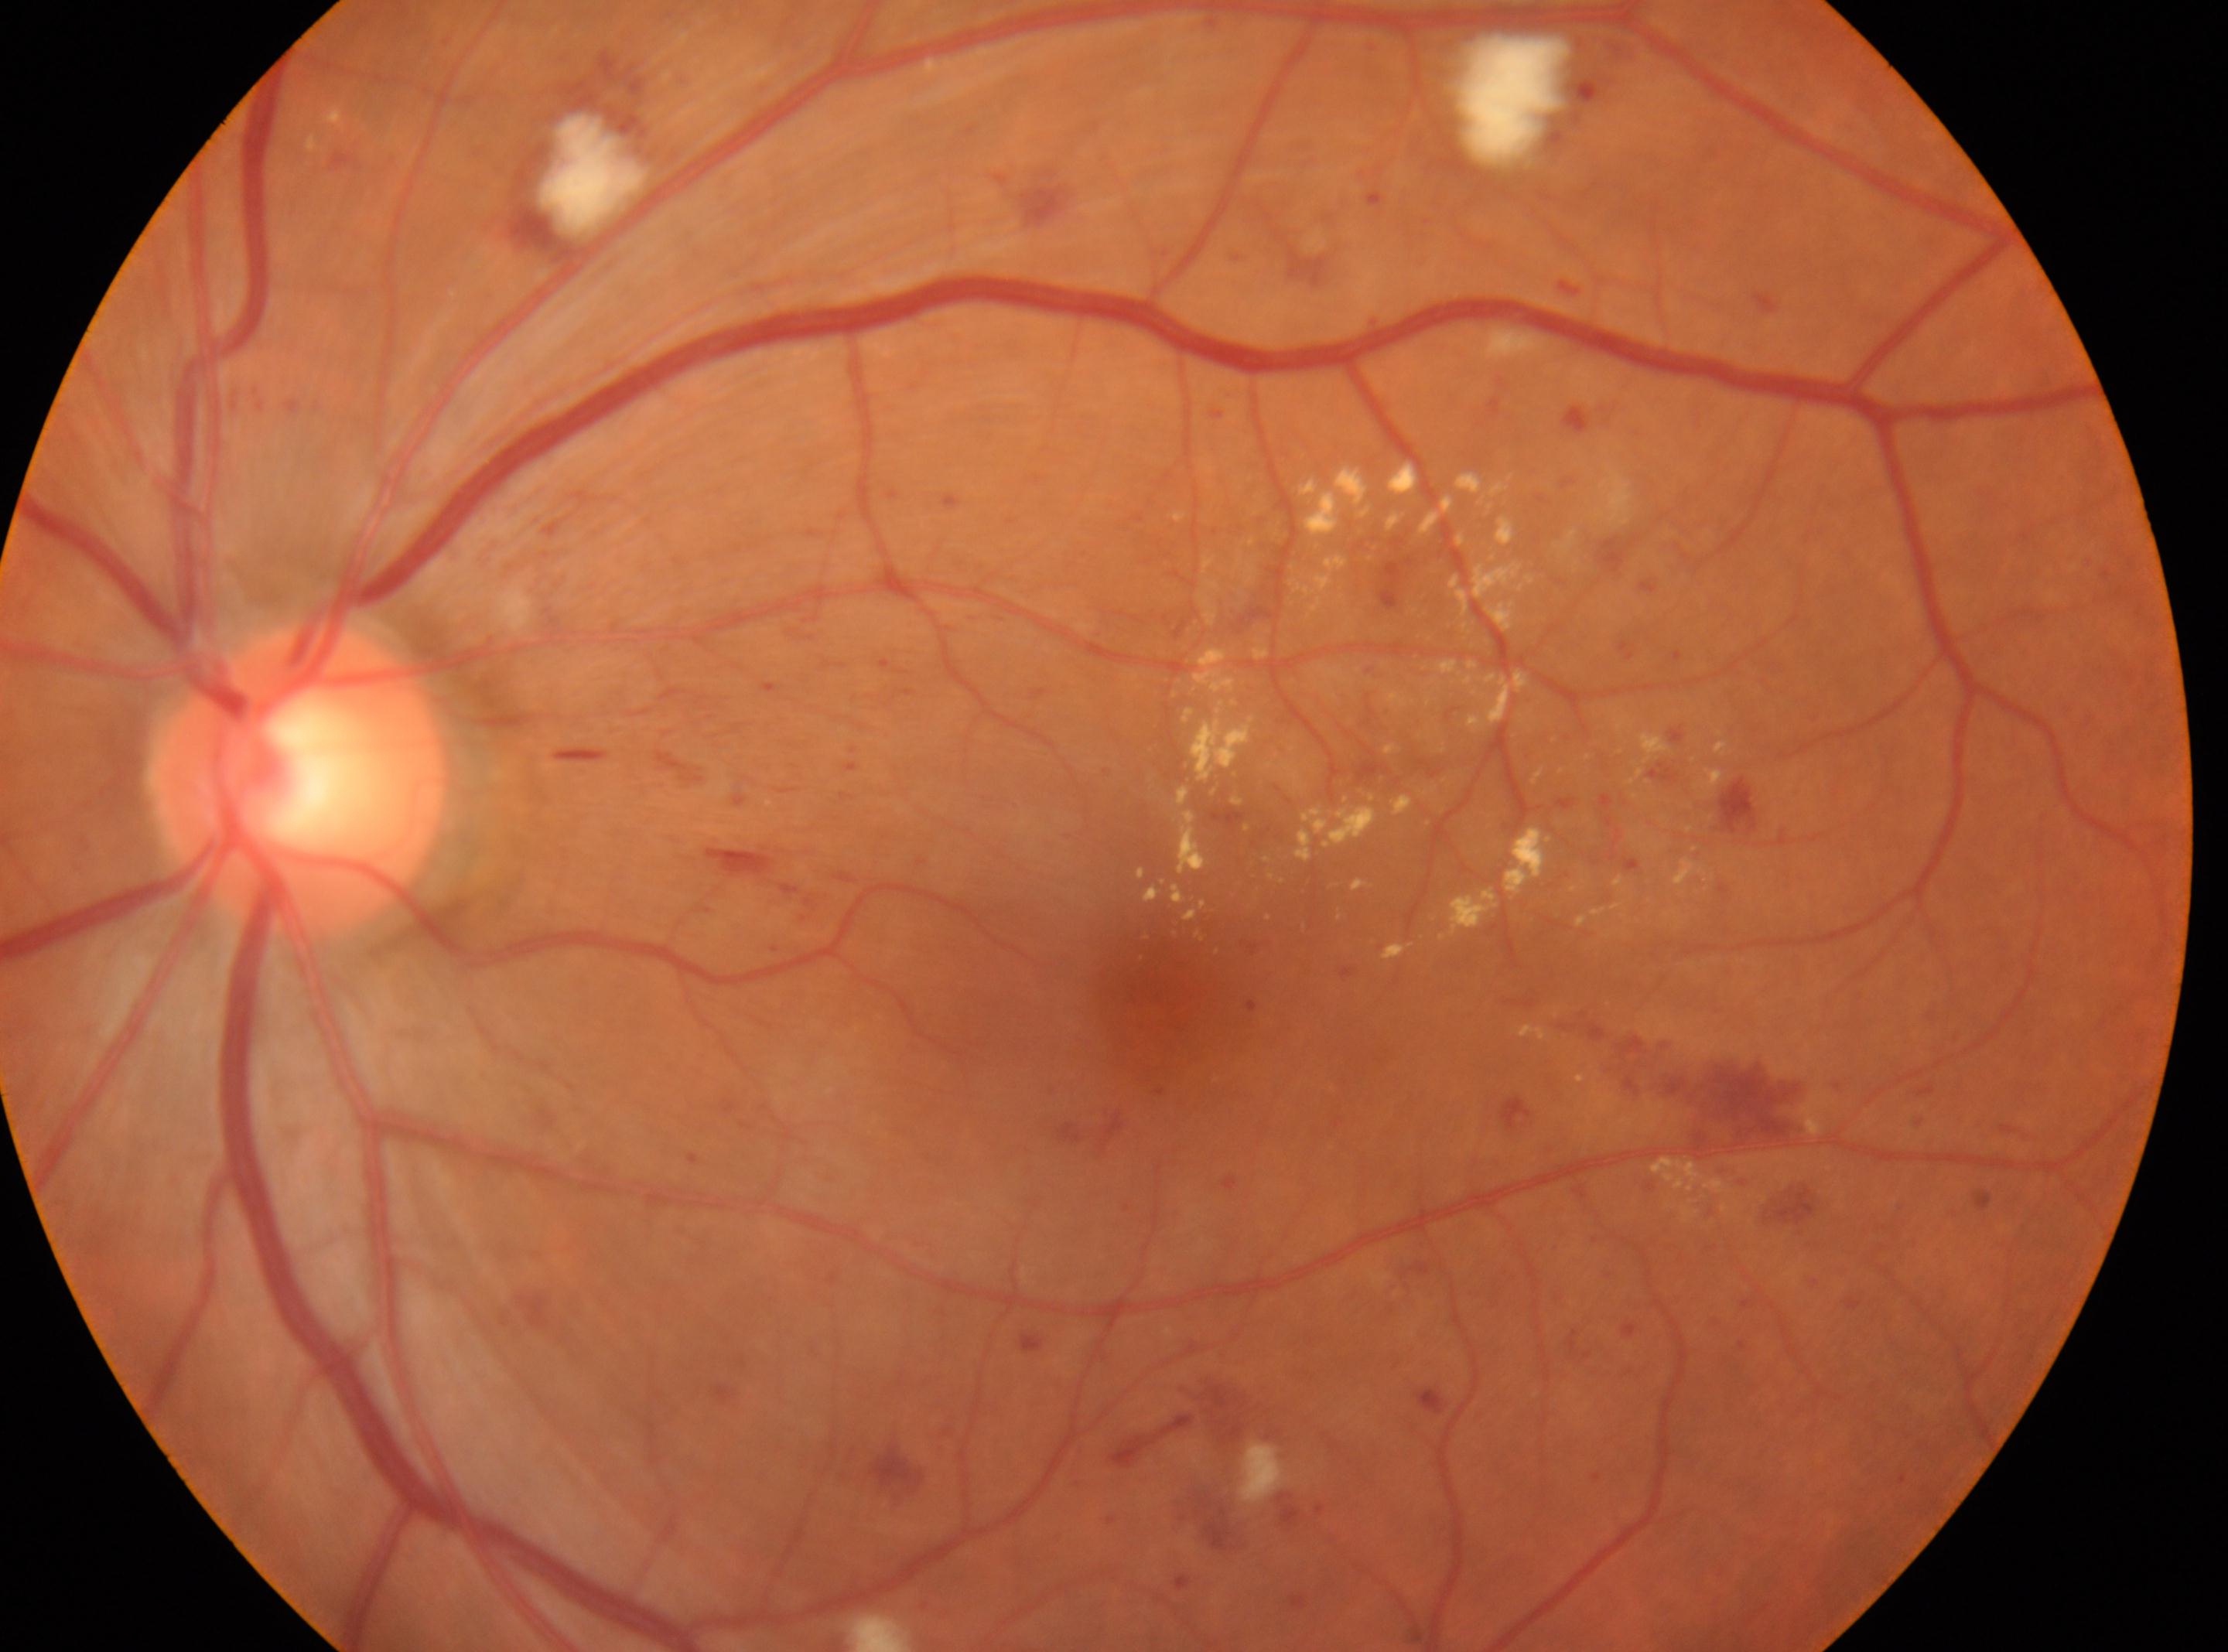 Q: What is the DR grade?
A: severe NPDR (3)
Q: Where is the fovea?
A: x=1145, y=984
Q: What is the laterality?
A: left
Q: Optic disc center?
A: x=300, y=780